1240 x 1240 pixels · pediatric retinal photograph (wide-field):
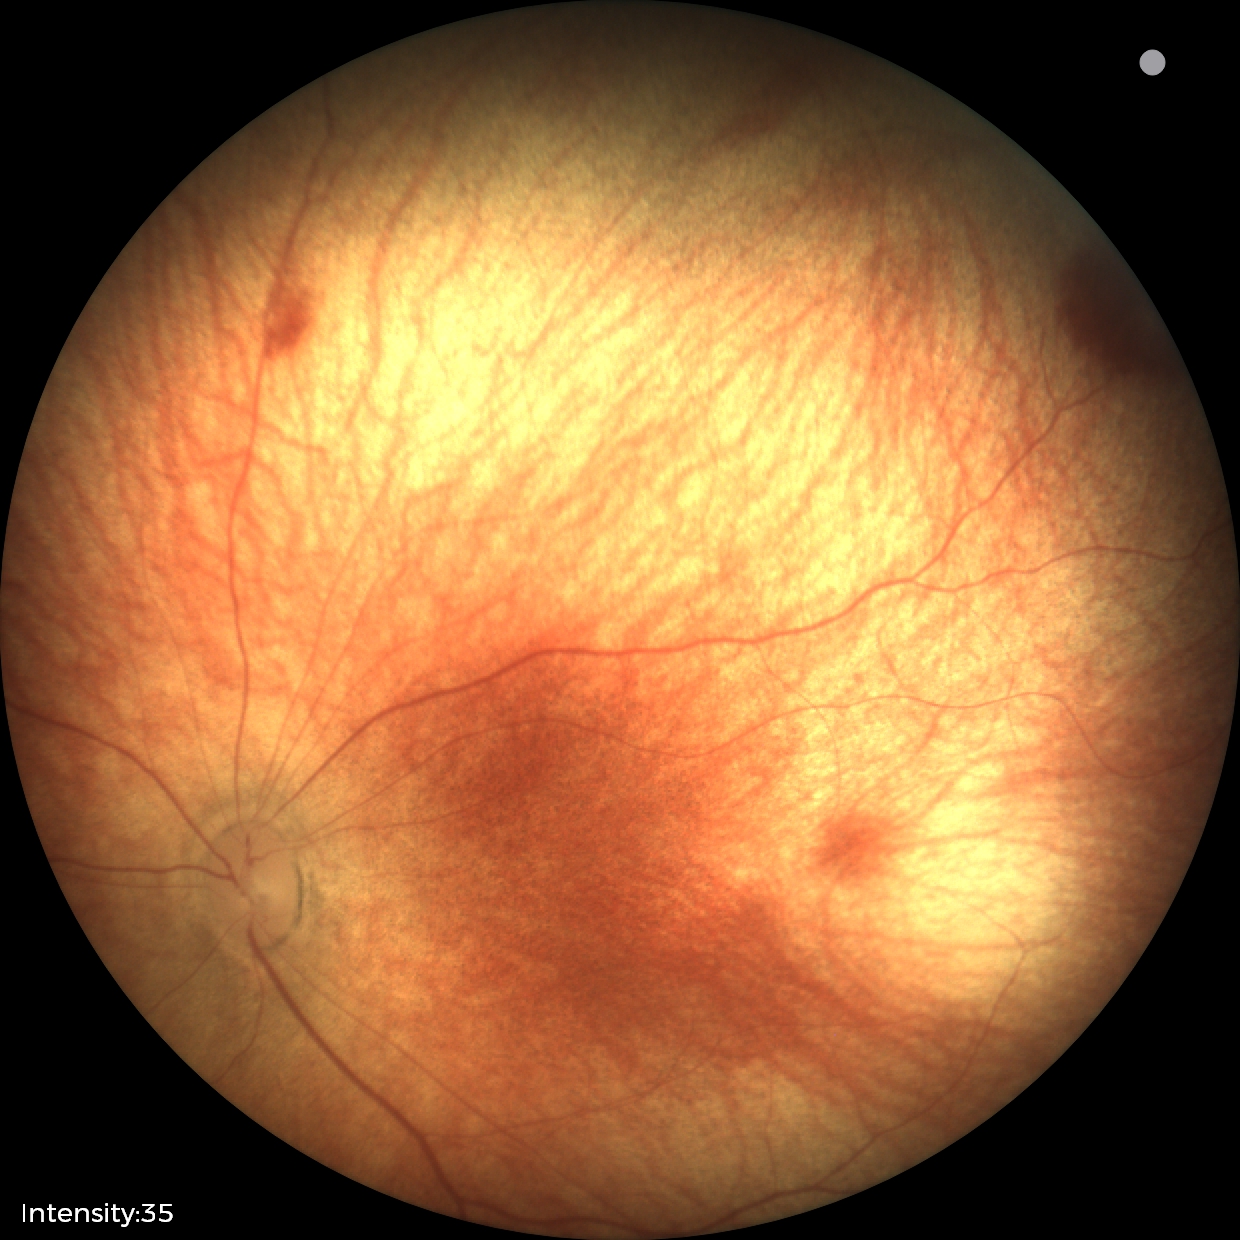
Screening diagnosis = retinal hemorrhages